30° FOV:
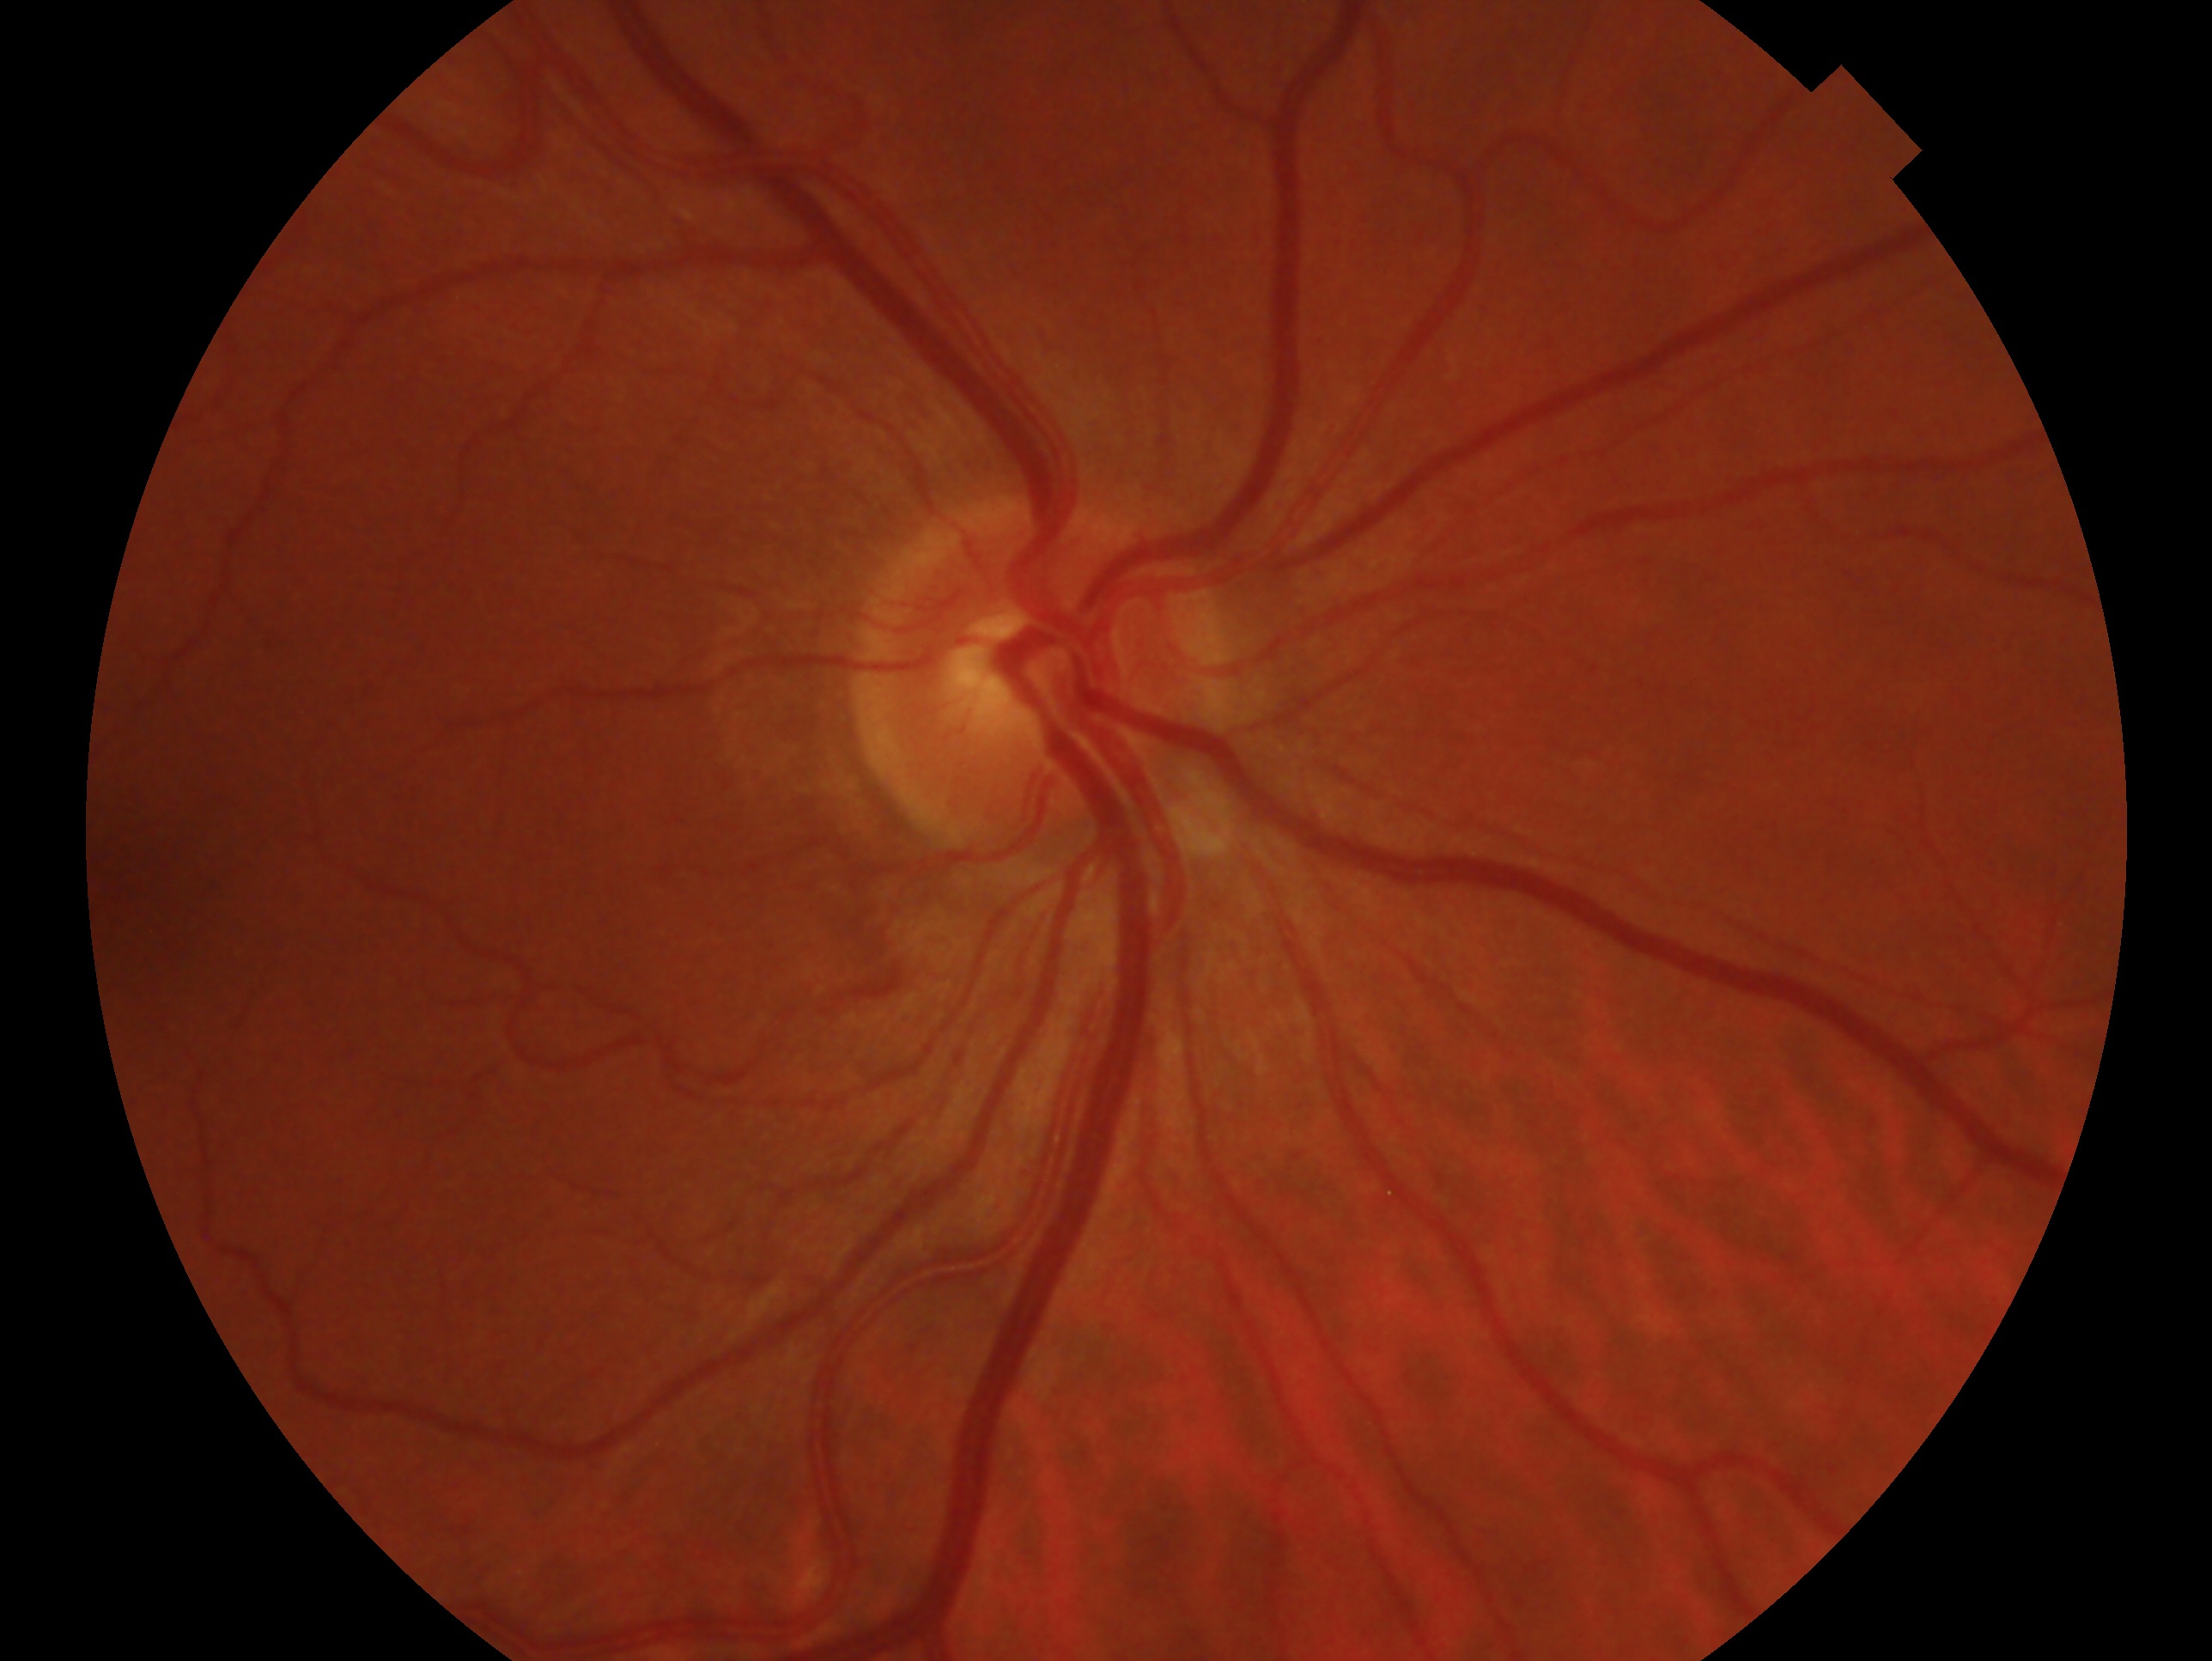 Eye: right eye.
Diagnosis — no glaucoma.